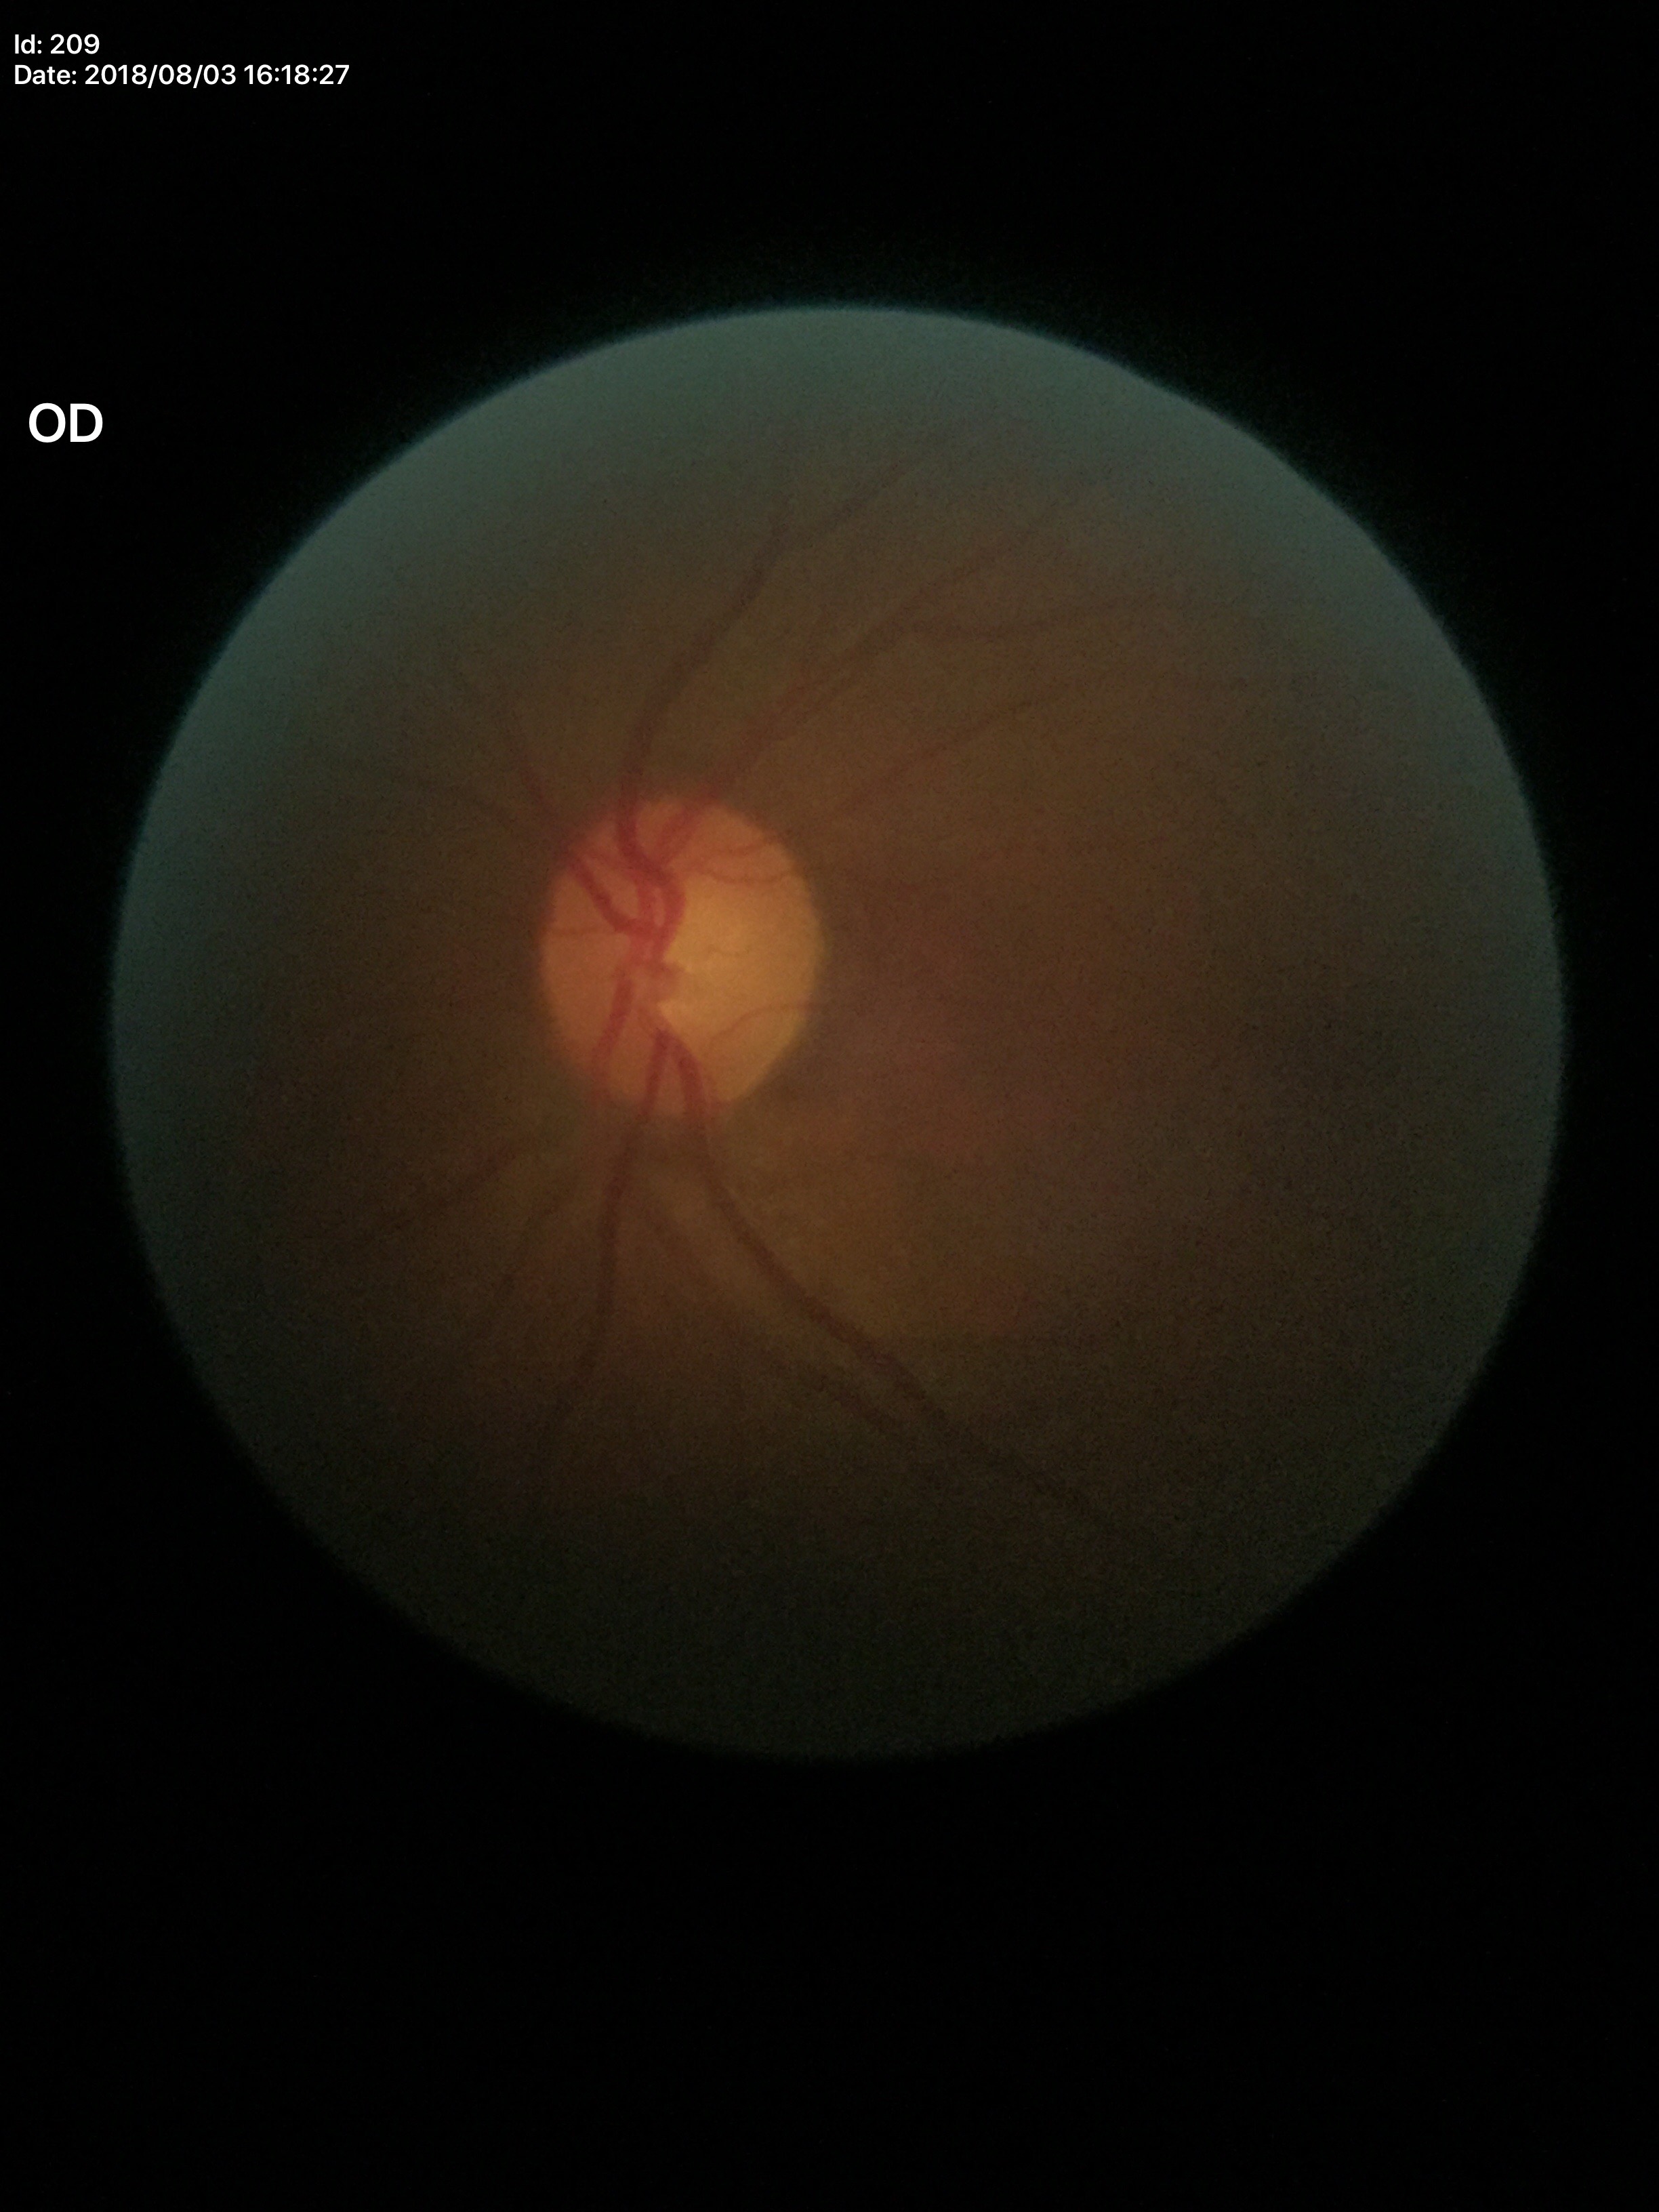

Glaucoma screening impression: no suspicious findings.
Vertical cup-to-disc ratio of 0.56.